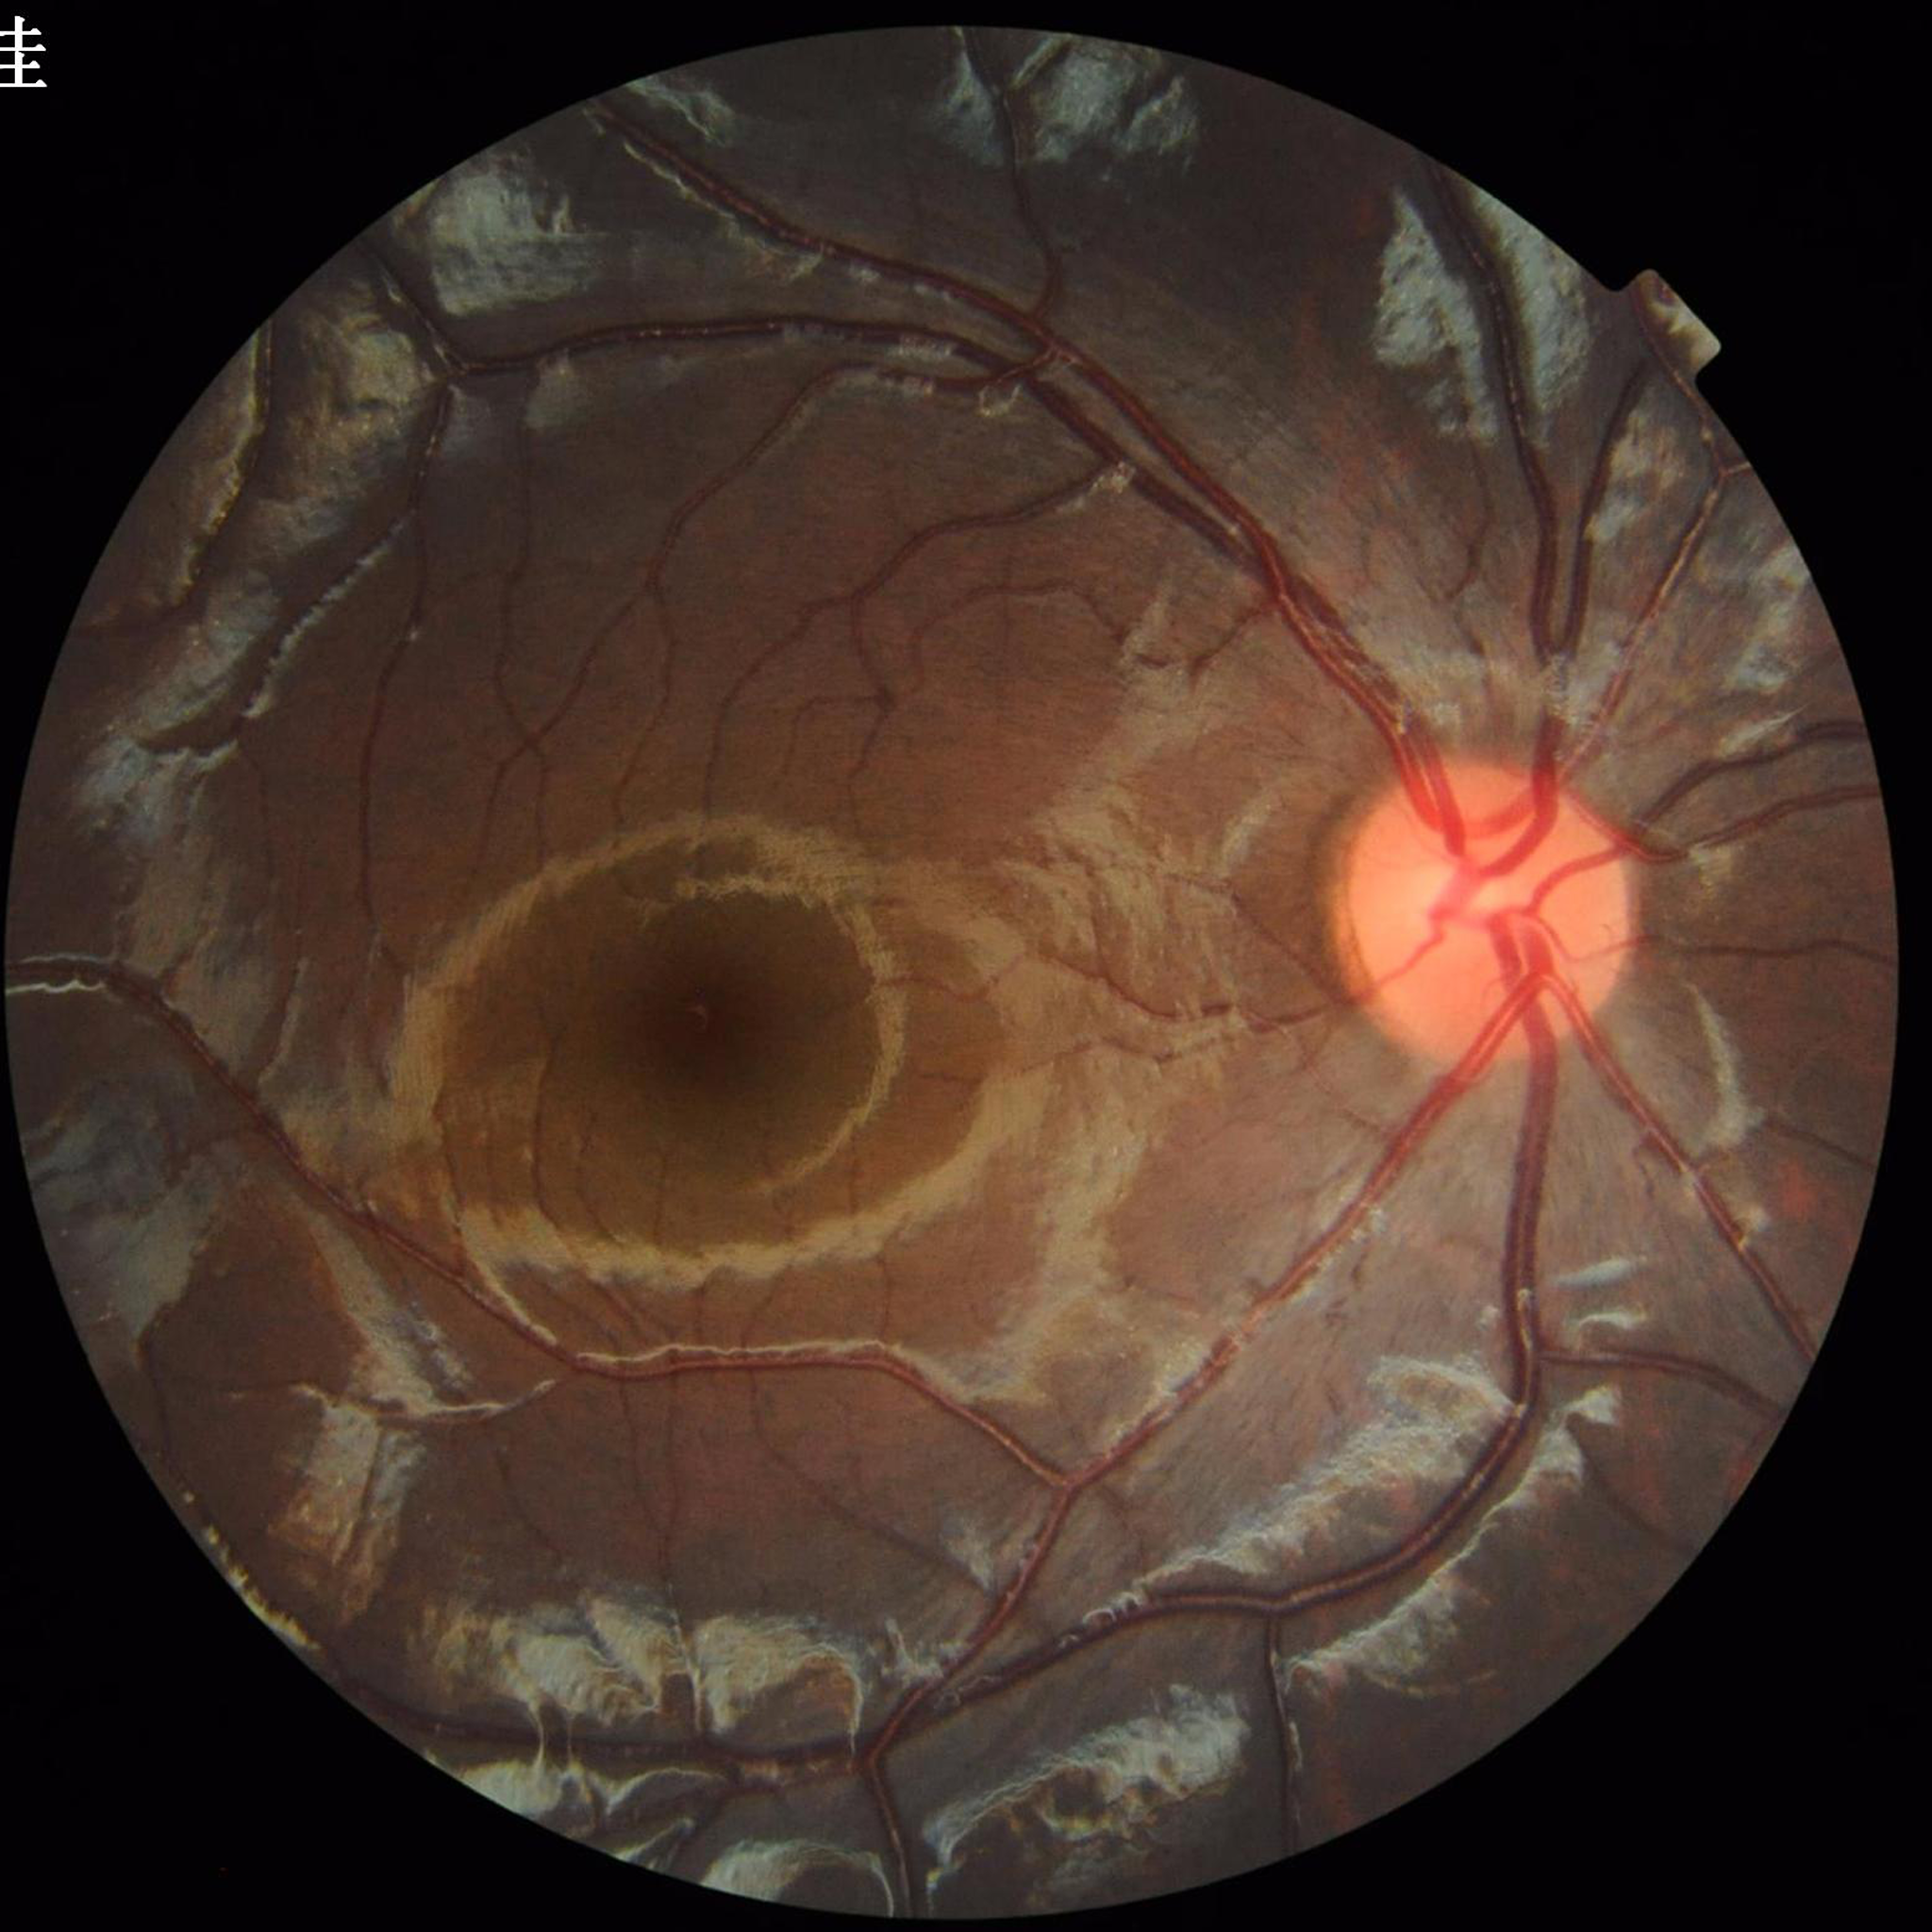
{
  "image_quality": "no quality issues identified",
  "diagnosis": "no AMD, diabetic retinopathy, or glaucoma"
}